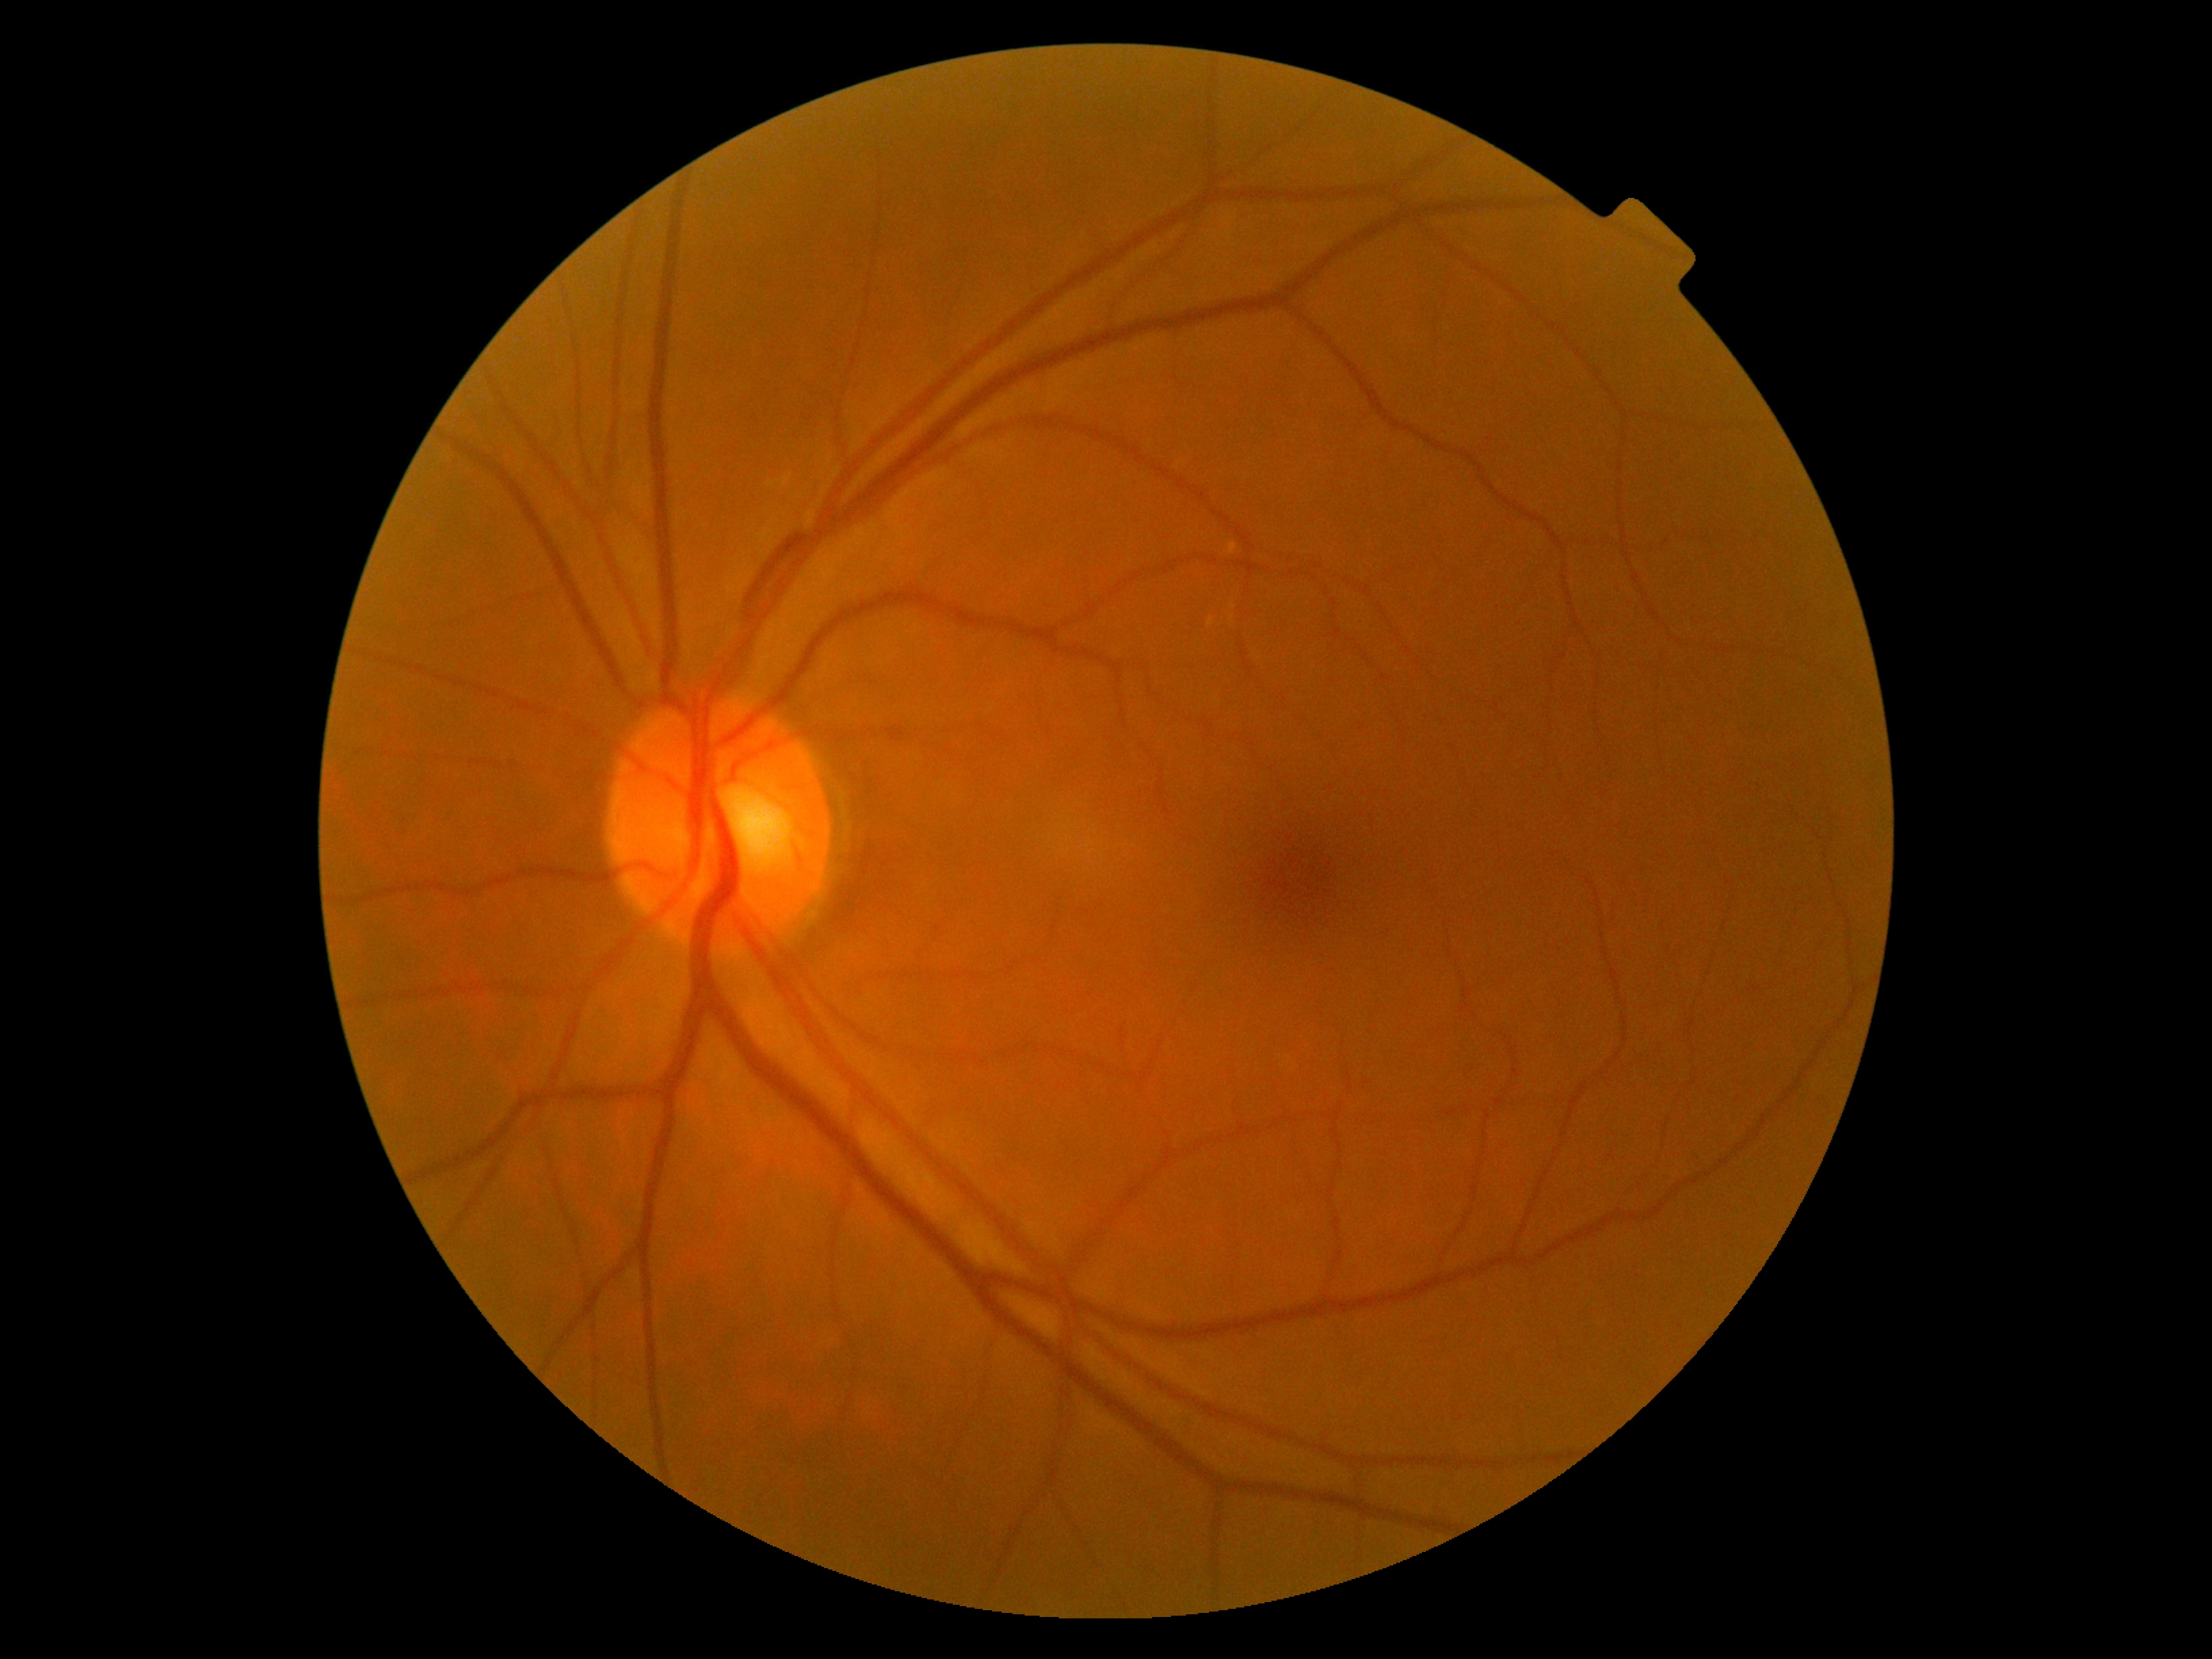
dr_grade: no apparent diabetic retinopathy (grade 0) — no visible signs of diabetic retinopathy
dr_impression: negative for DR